45° FOV. 848x848. Graded on the modified Davis scale: 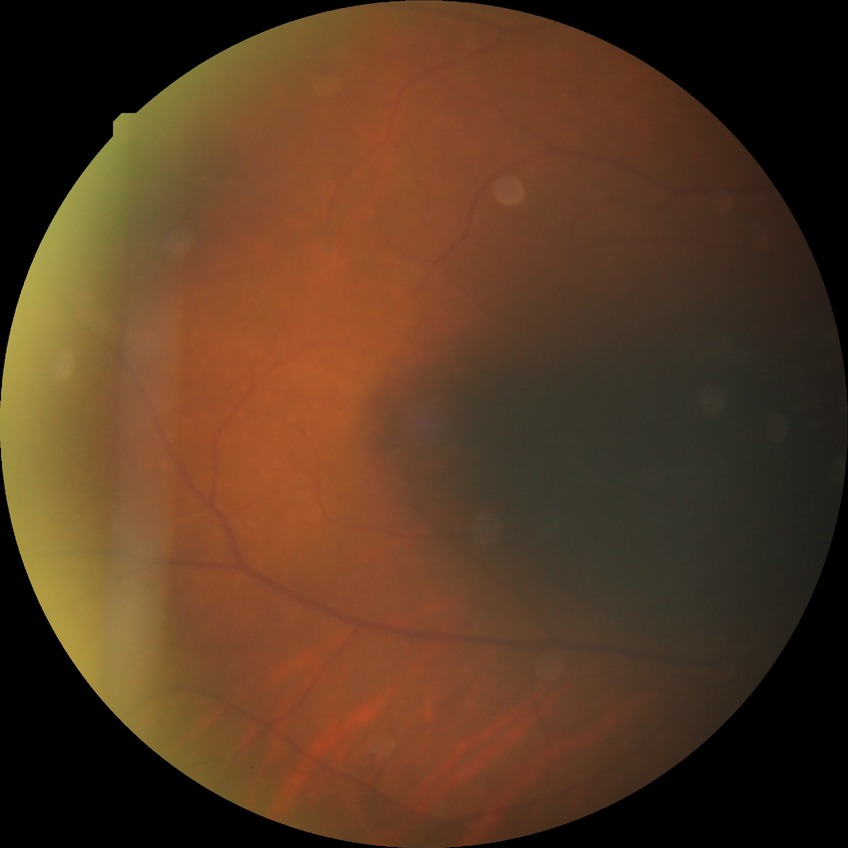 No apparent diabetic retinopathy. Davis stage: NDR.